Wide-field fundus photograph of an infant — 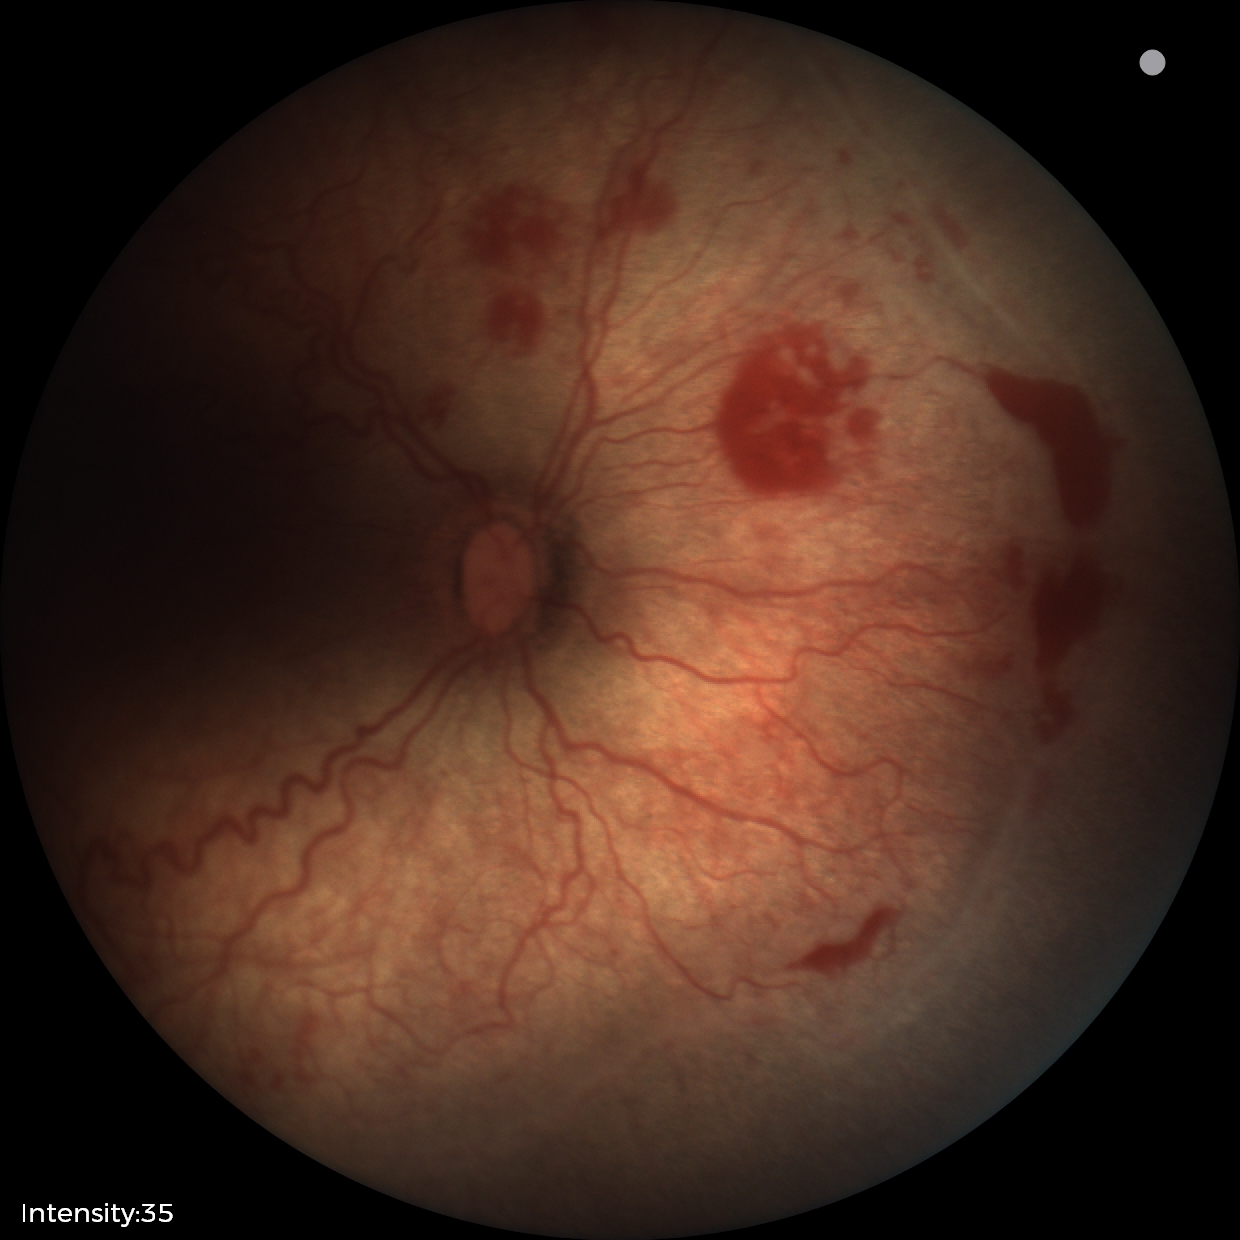 Plus disease = present | diagnosis = retinopathy of prematurity (ROP) stage 2.